Infant wide-field retinal image · 1240x1240.
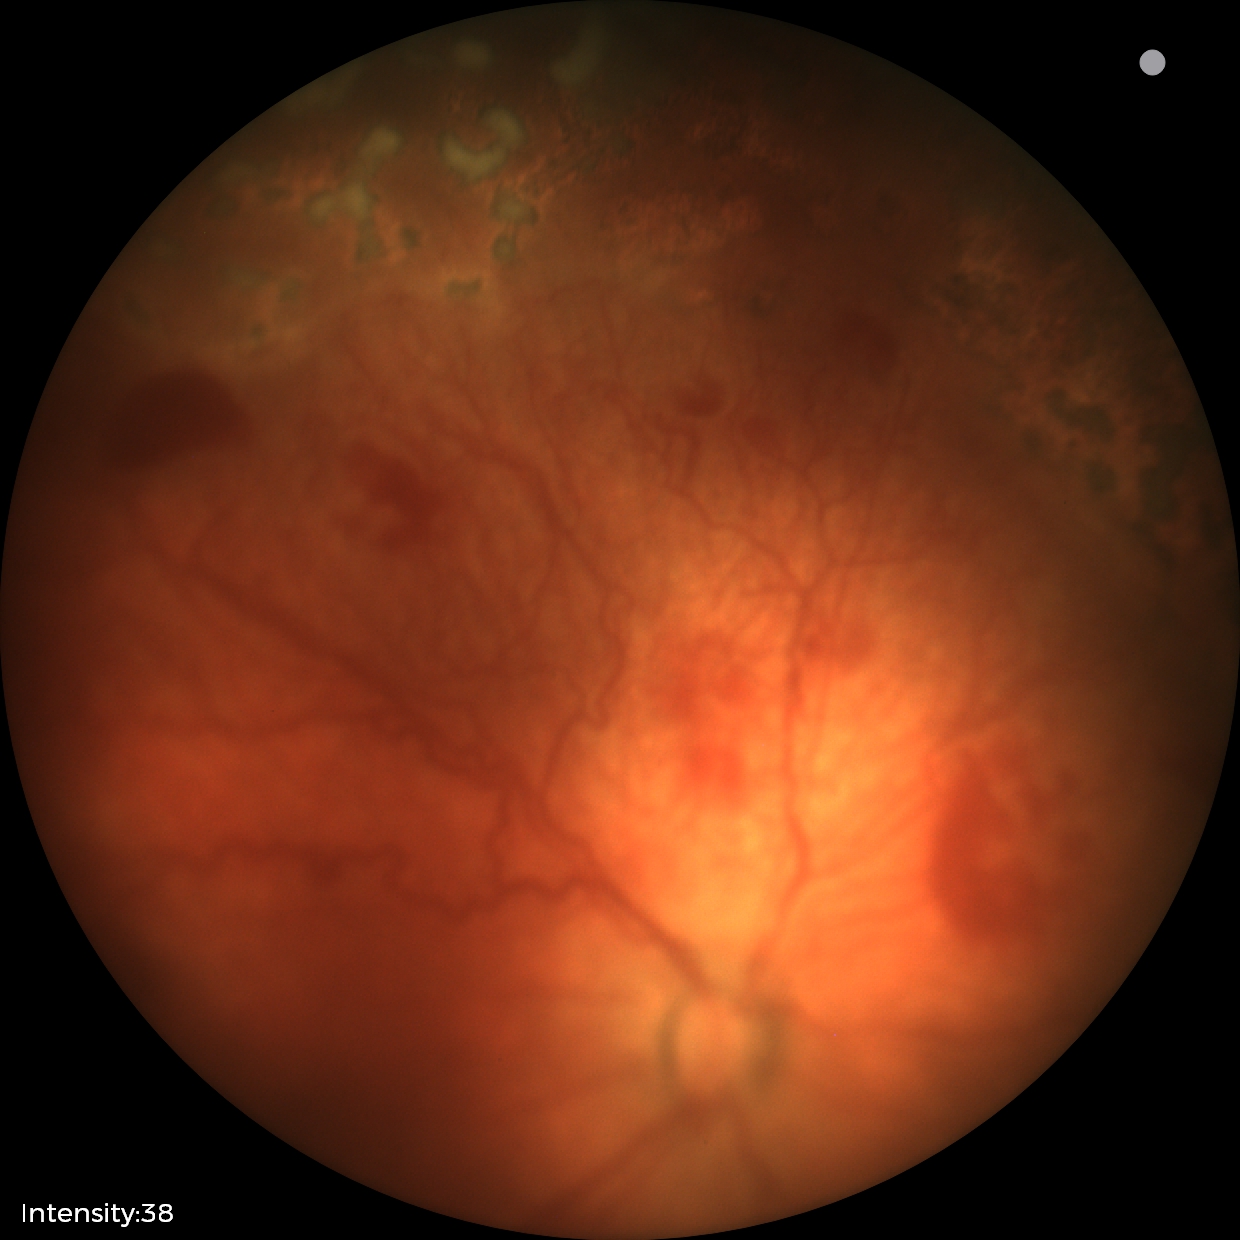 Diagnosis from this screening exam: status post retinopathy of prematurity.
Without plus disease.